Modified Davis classification:
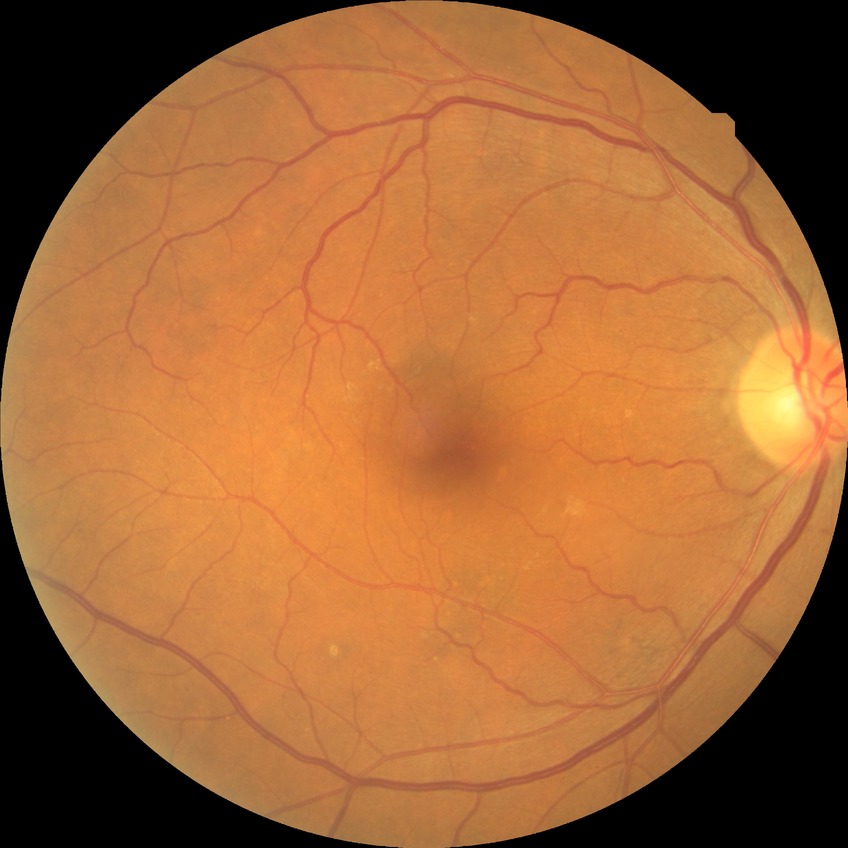

Davis stage is NDR.
No diabetic retinal disease findings.